2048x1536px:
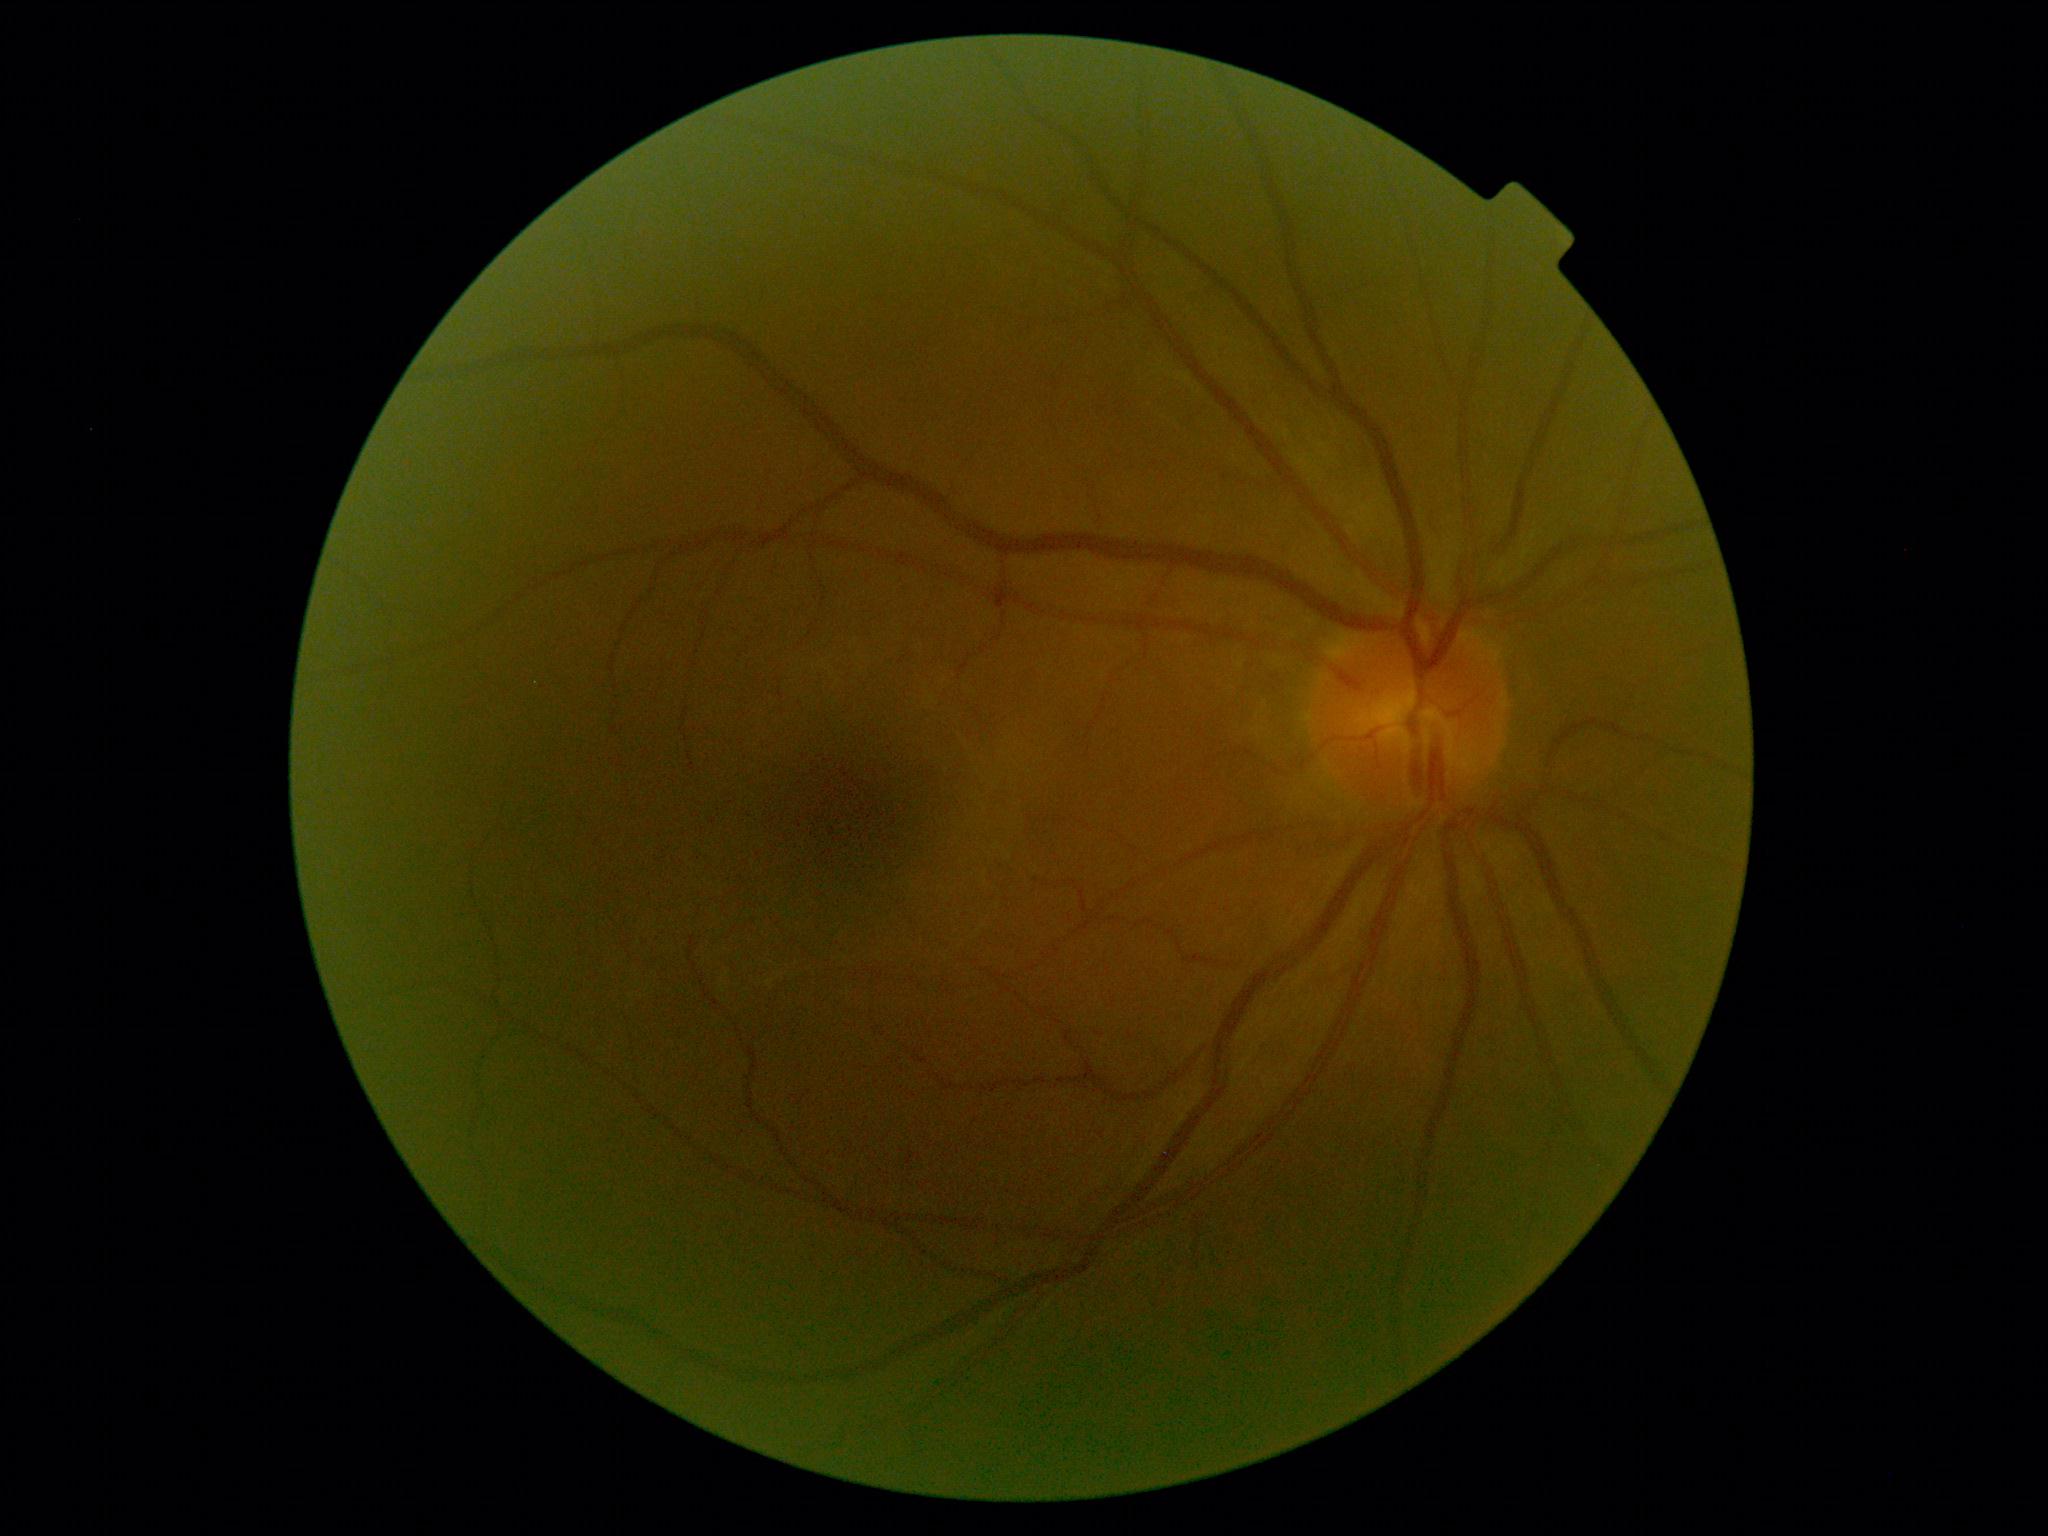
Diabetic retinopathy severity: grade 0. No apparent diabetic retinopathy.